Acquired on the Natus RetCam Envision; pediatric retinal photograph (wide-field); 1440 x 1080 pixels:
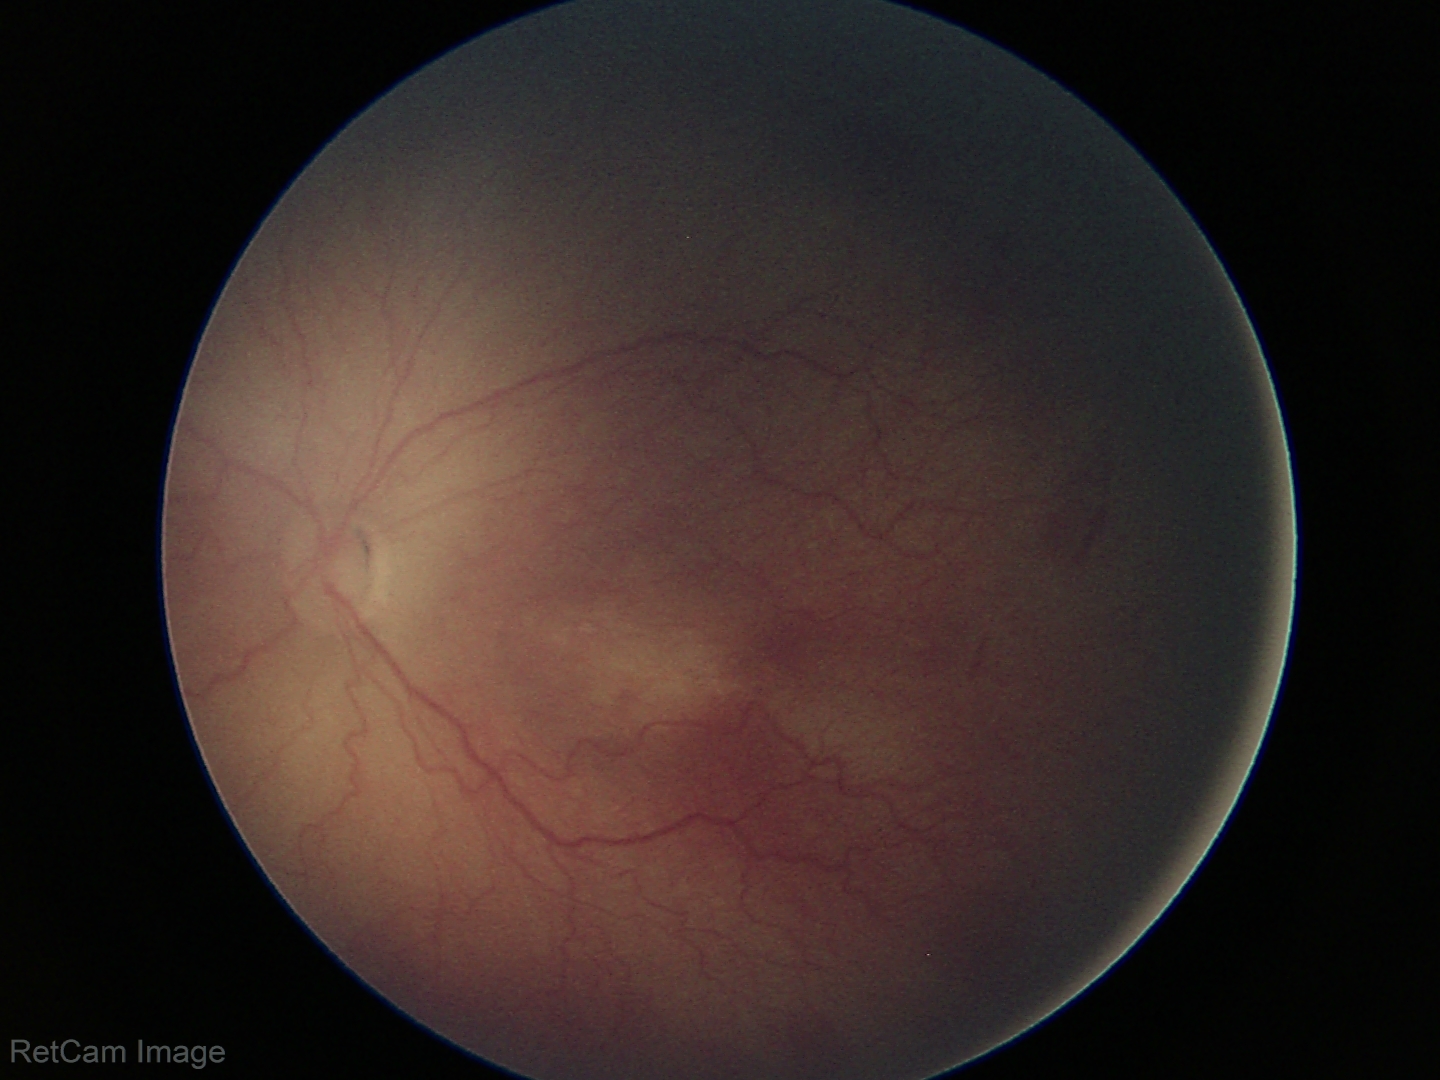 Diagnosis = retinopathy of prematurity stage 2; plus form = absent.